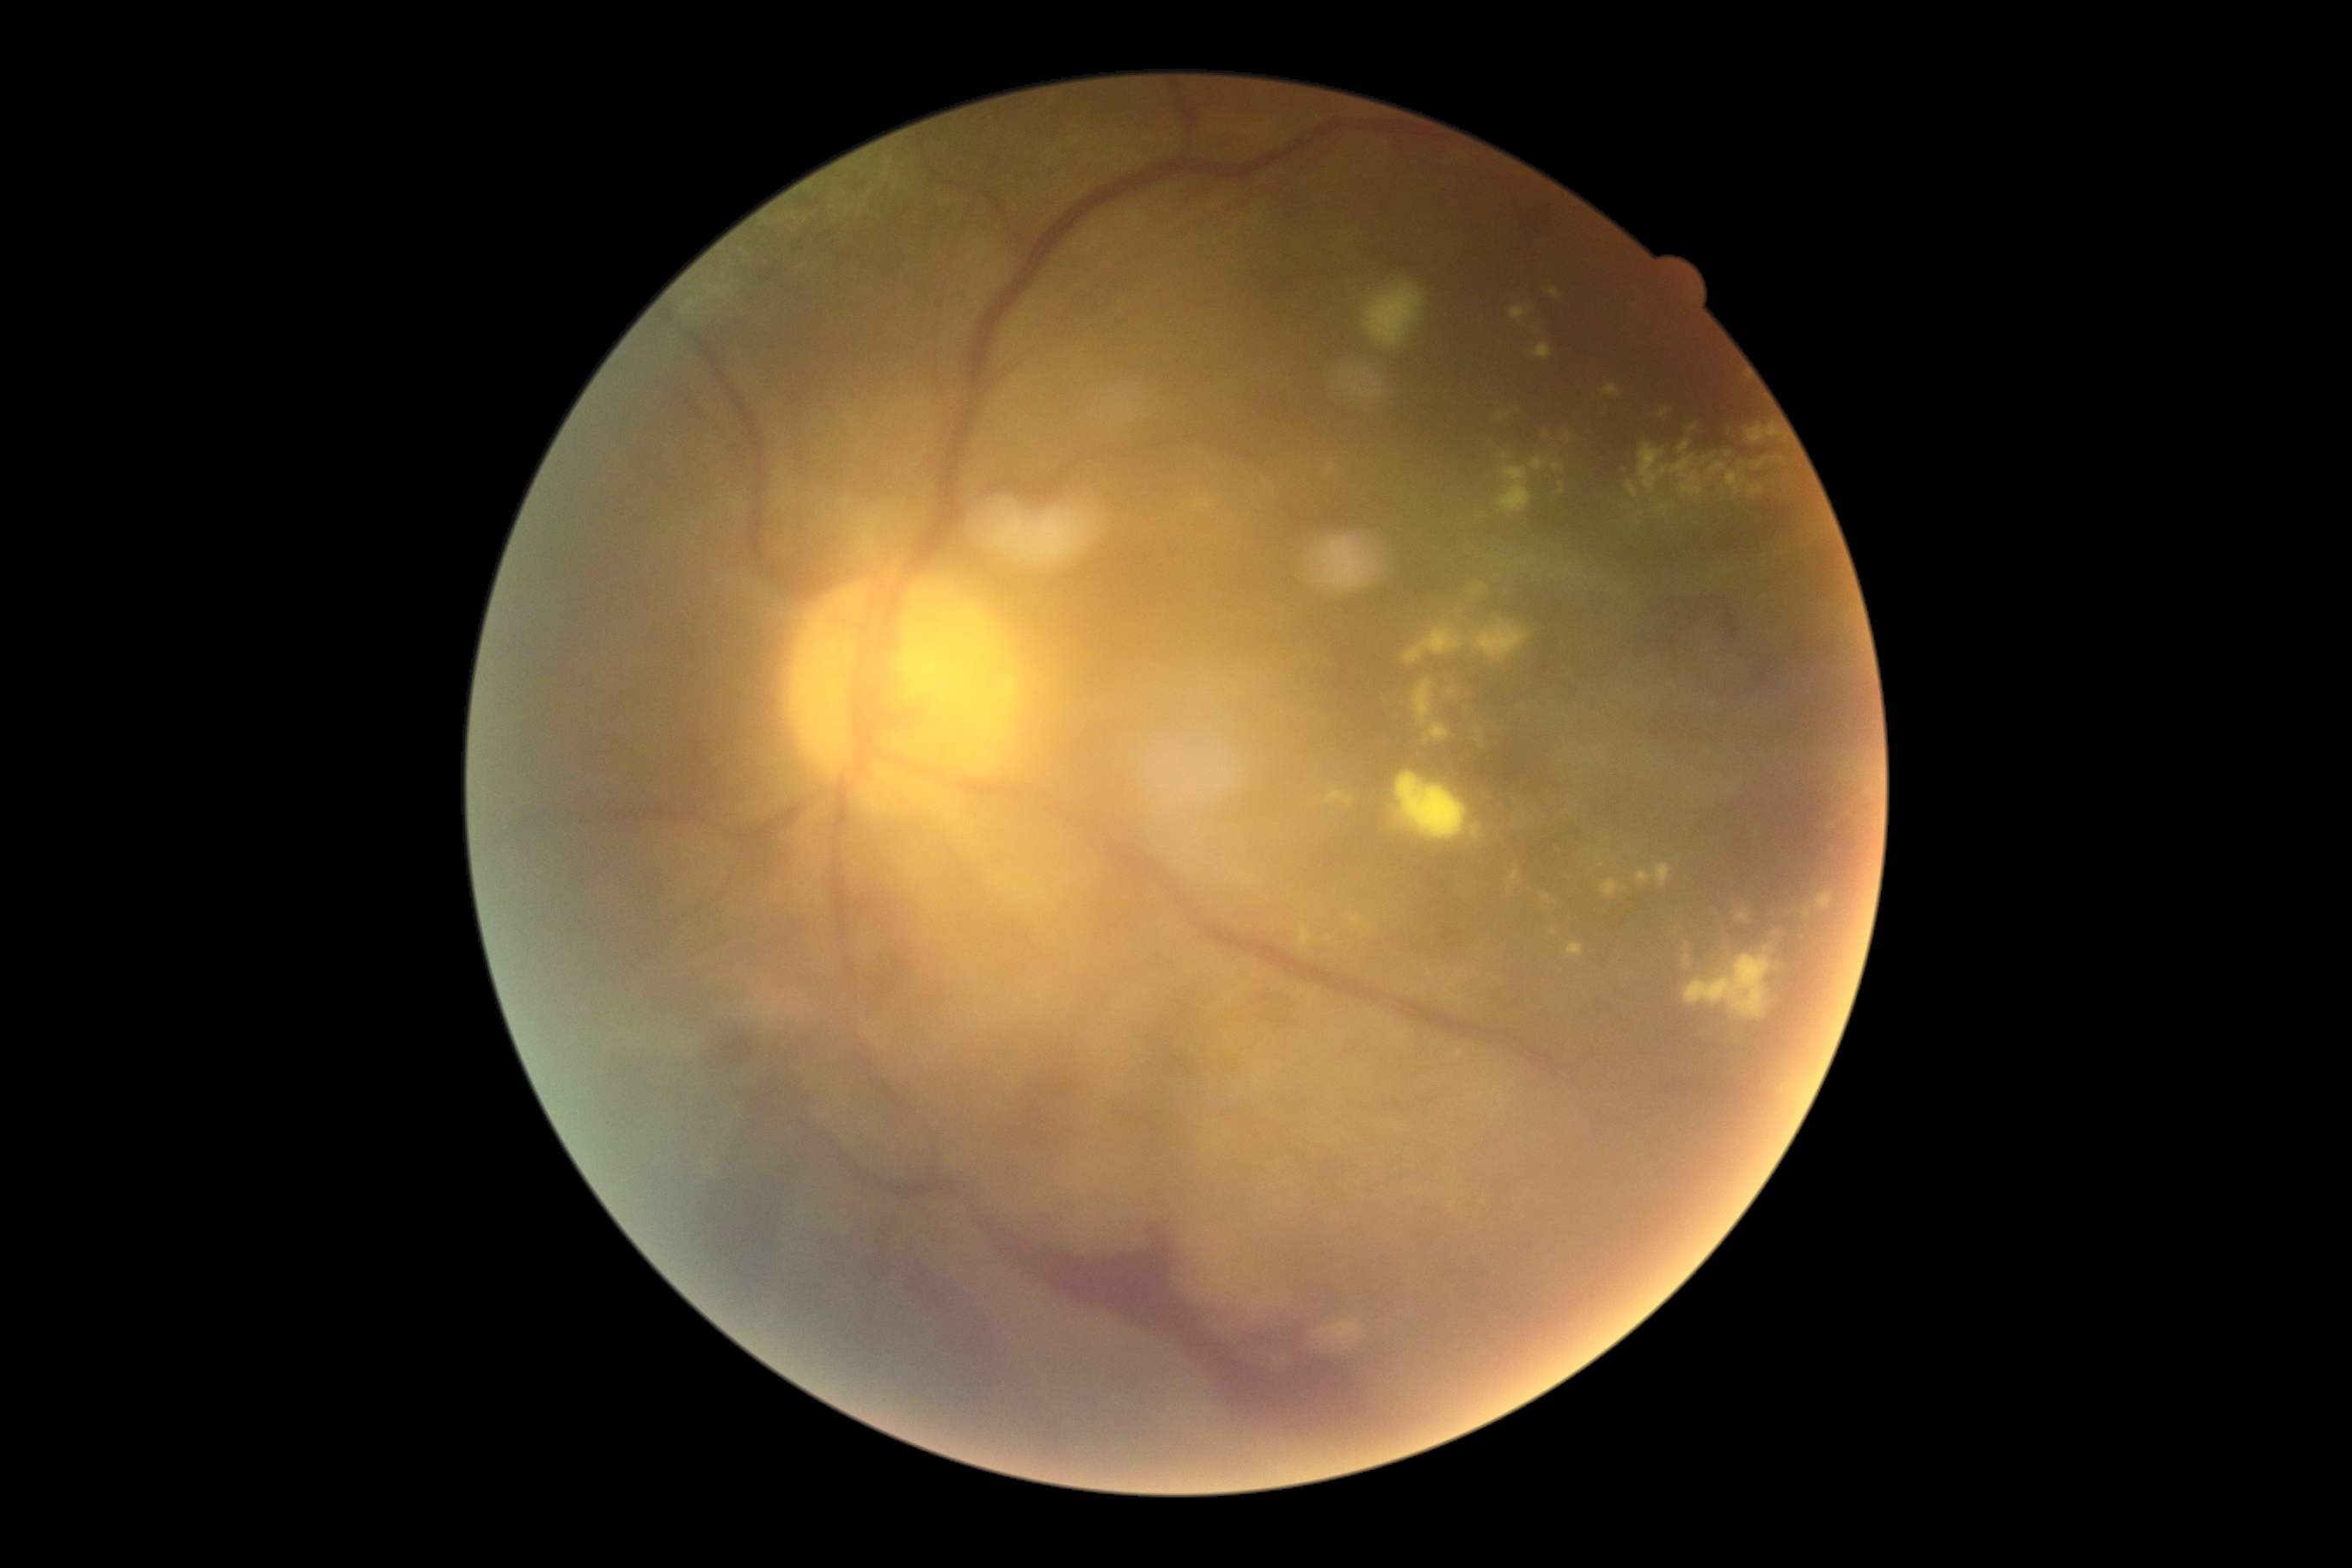
DR stage is PDR (grade 4). EXs are present, including at [left=1507, top=867, right=1521, bottom=897]; [left=1602, top=879, right=1629, bottom=900]; [left=1474, top=622, right=1528, bottom=661]; [left=1426, top=972, right=1435, bottom=979]; [left=1603, top=386, right=1620, bottom=398]; [left=1689, top=424, right=1698, bottom=432]; [left=1309, top=993, right=1314, bottom=1001]; [left=1679, top=441, right=1689, bottom=455]; [left=1627, top=482, right=1638, bottom=499]; [left=1395, top=773, right=1469, bottom=842]; [left=1498, top=412, right=1510, bottom=420]; [left=1567, top=945, right=1584, bottom=959]. EXs (small, approximate centers) near 1727:573; 1568:436; 1452:692; 1451:985.